Davis DR grading
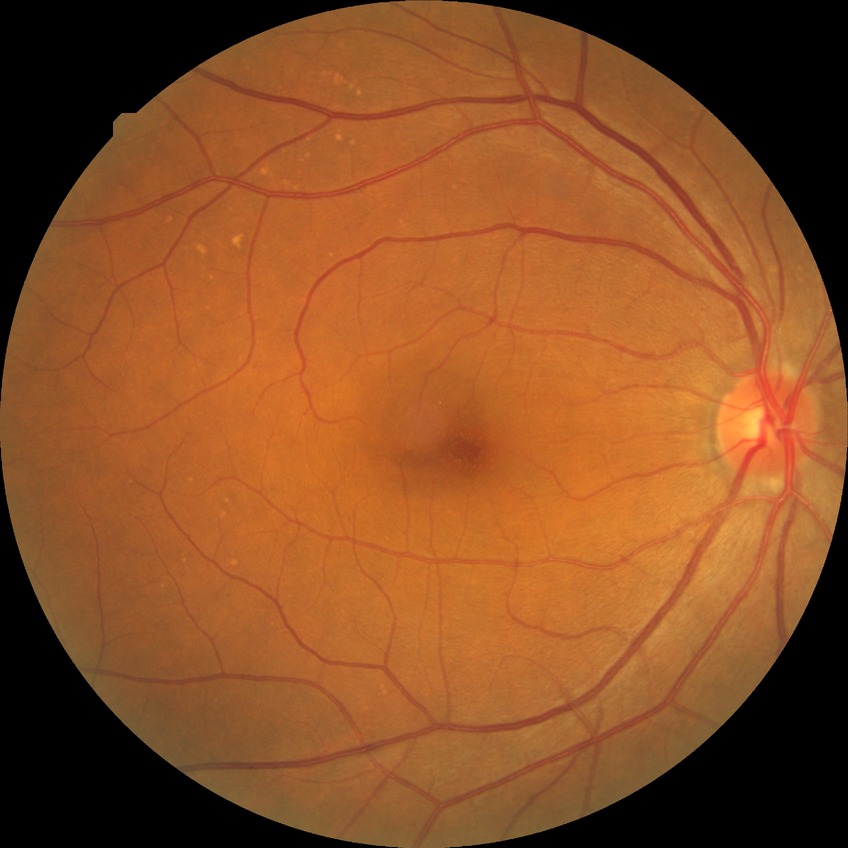 Davis grade: NDR. No signs of diabetic retinopathy.